Color fundus photograph · acquired with a NIDEK AFC-230 · diabetic retinopathy graded by the modified Davis classification · 848x848px · nonmydriatic fundus photograph.
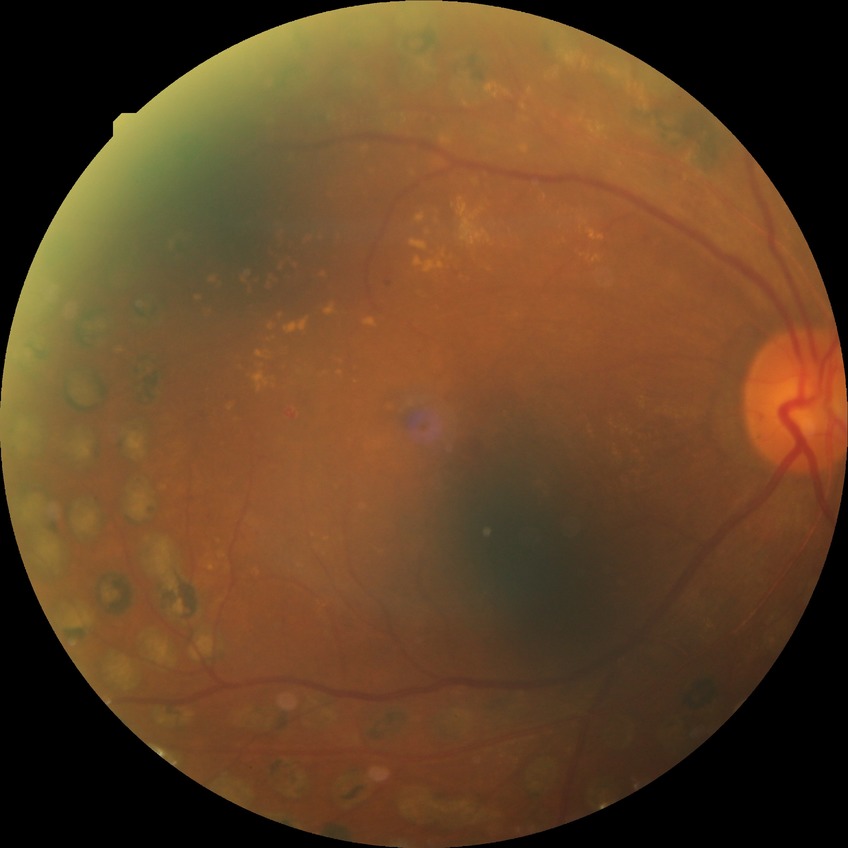
diabetic retinopathy stage: proliferative diabetic retinopathy